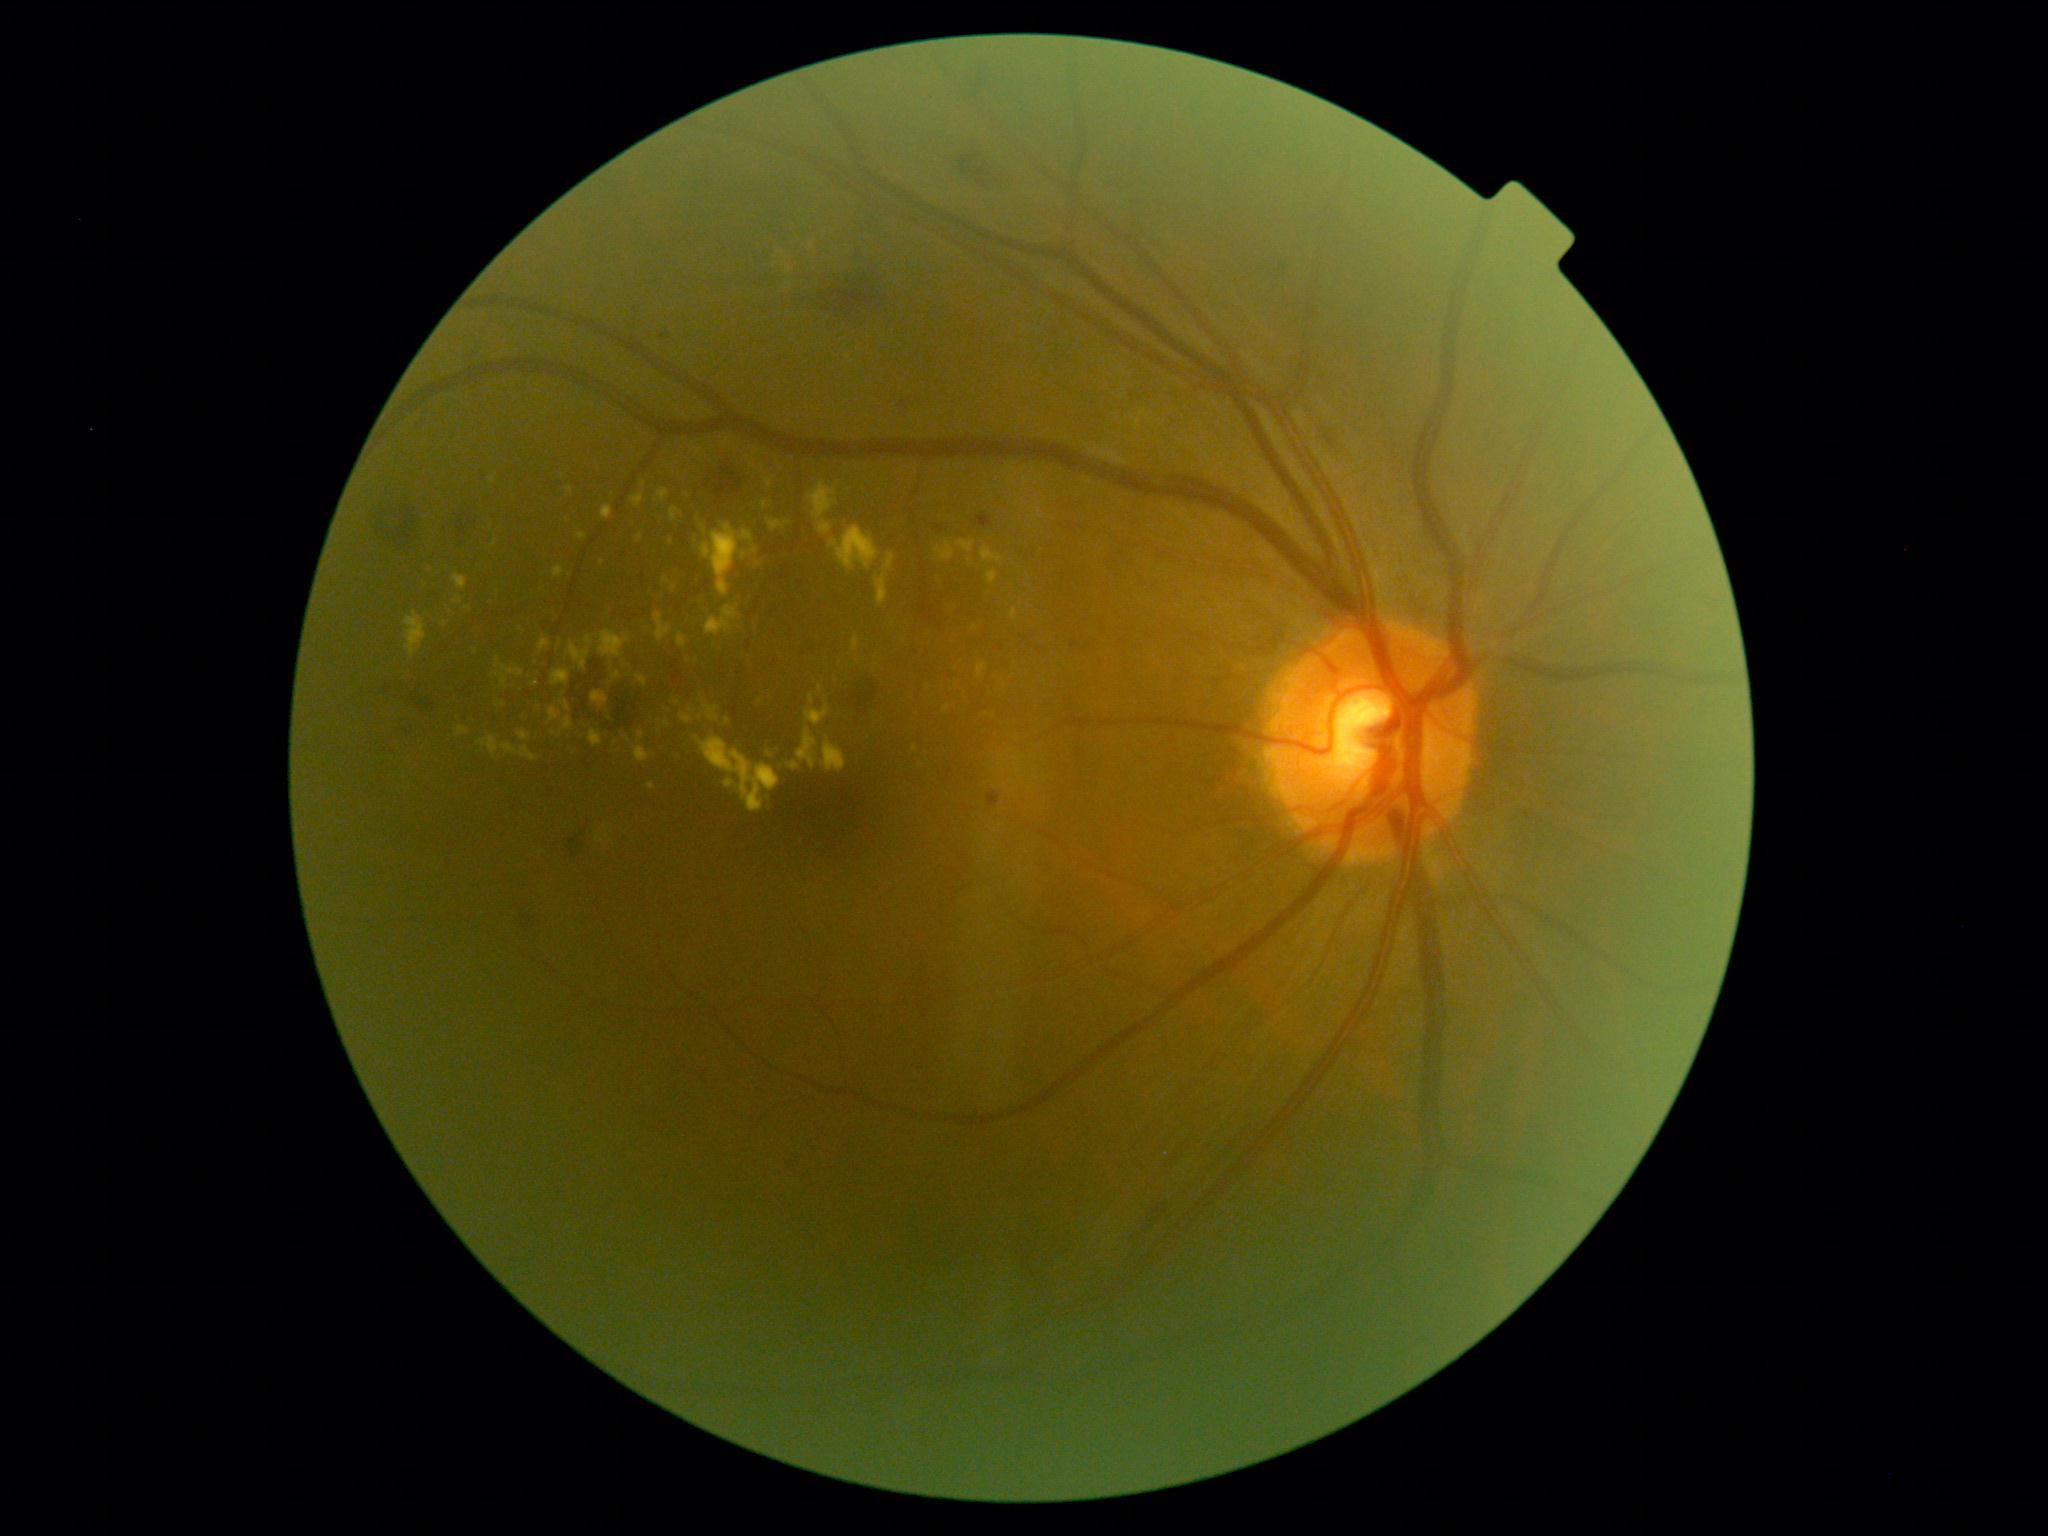 DR stage is moderate NPDR (grade 2) — more than just microaneurysms but less than severe NPDR; non-proliferative diabetic retinopathy.
EXs (partial list) at 701/523/758/598; 600/559/605/567; 1011/608/1018/621; 737/581/740/601; 704/701/719/723; 689/577/699/591; 671/508/682/522; 453/575/468/591; 655/612/673/643; 567/635/595/670; 549/709/562/723; 1001/760/1006/770.
Additional small EXs near 769/755; 445/625; 769/800; 554/734; 425/586.